240 x 240 pixels:
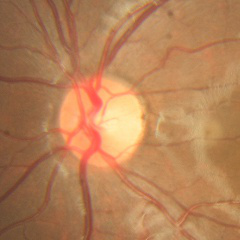
Demonstrates no signs of glaucoma.